No pharmacologic dilation
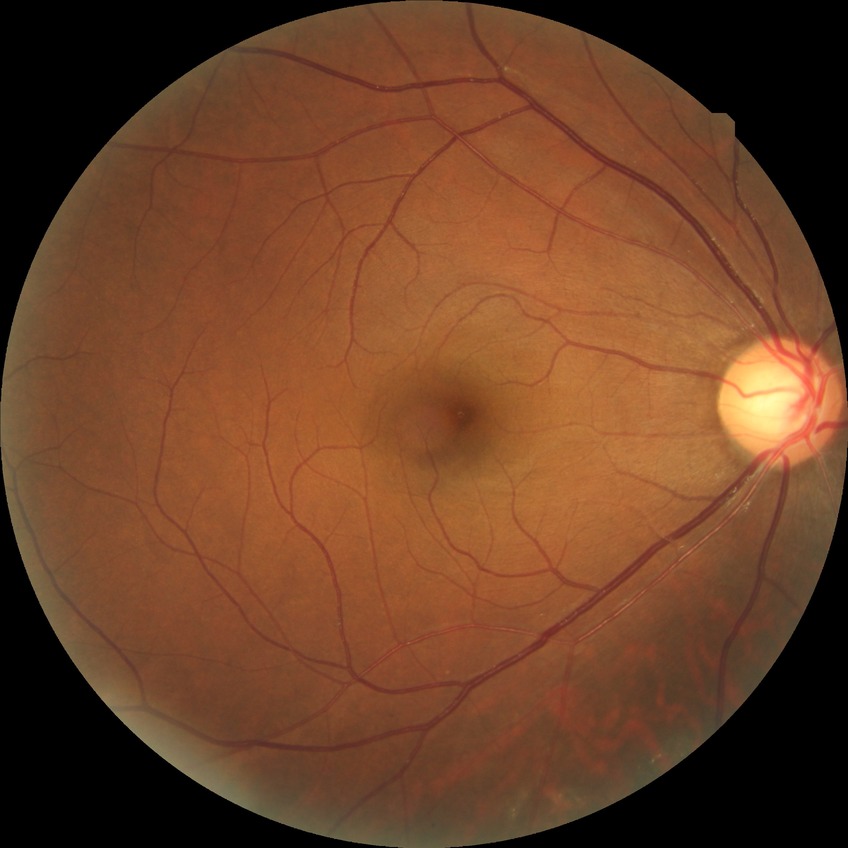 diabetic retinopathy grade = no diabetic retinopathy.